640x480px. Infant wide-field fundus photograph
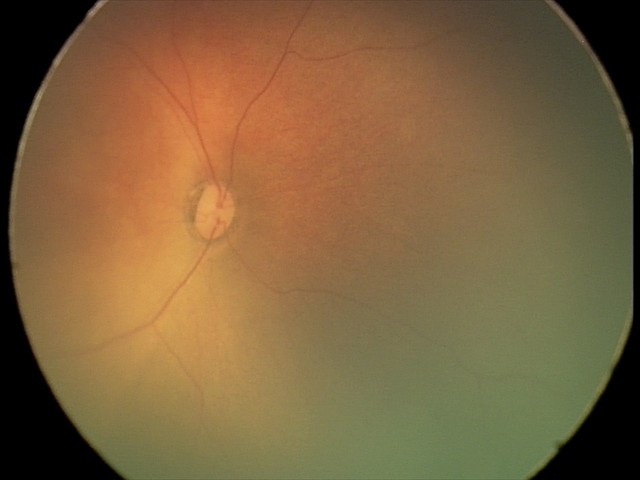

Impression: normal fundus examination.